2212 x 1672 pixels · fundus photo
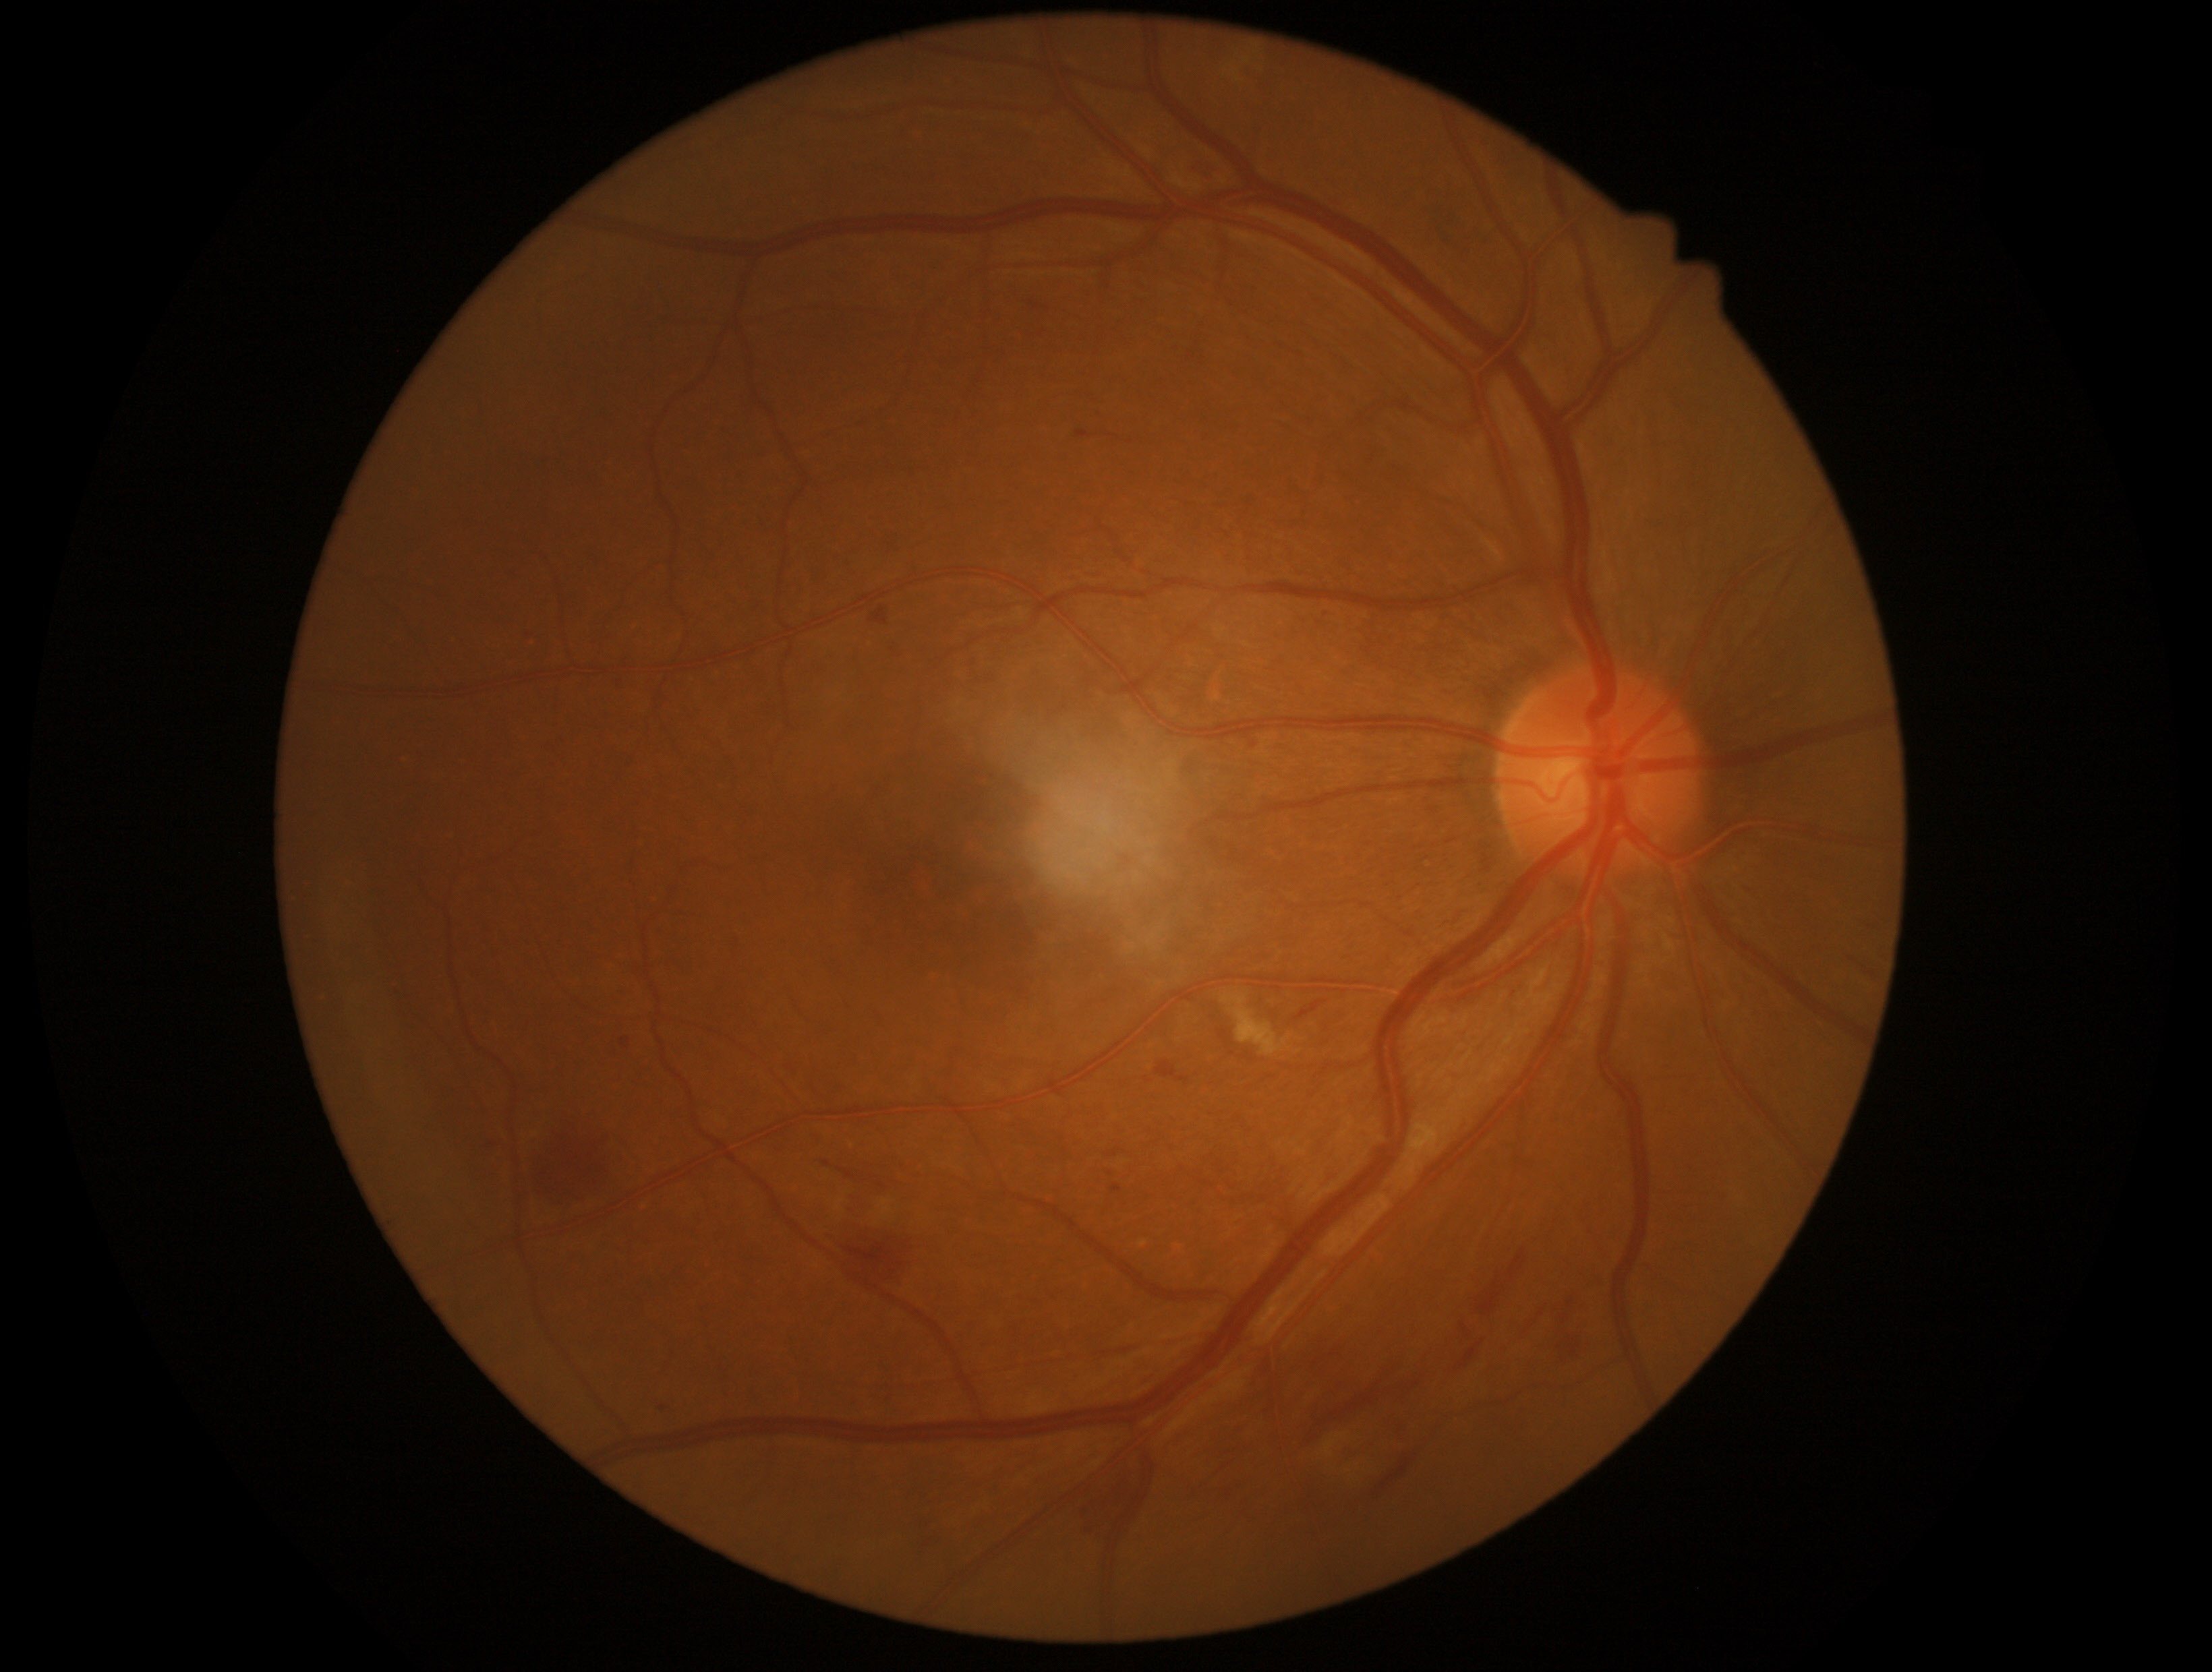

Diabetic retinopathy is 2/4.